Color fundus image · 50° FOV · pupil-dilated · image size 2361x1568 · macula at the center of the field — 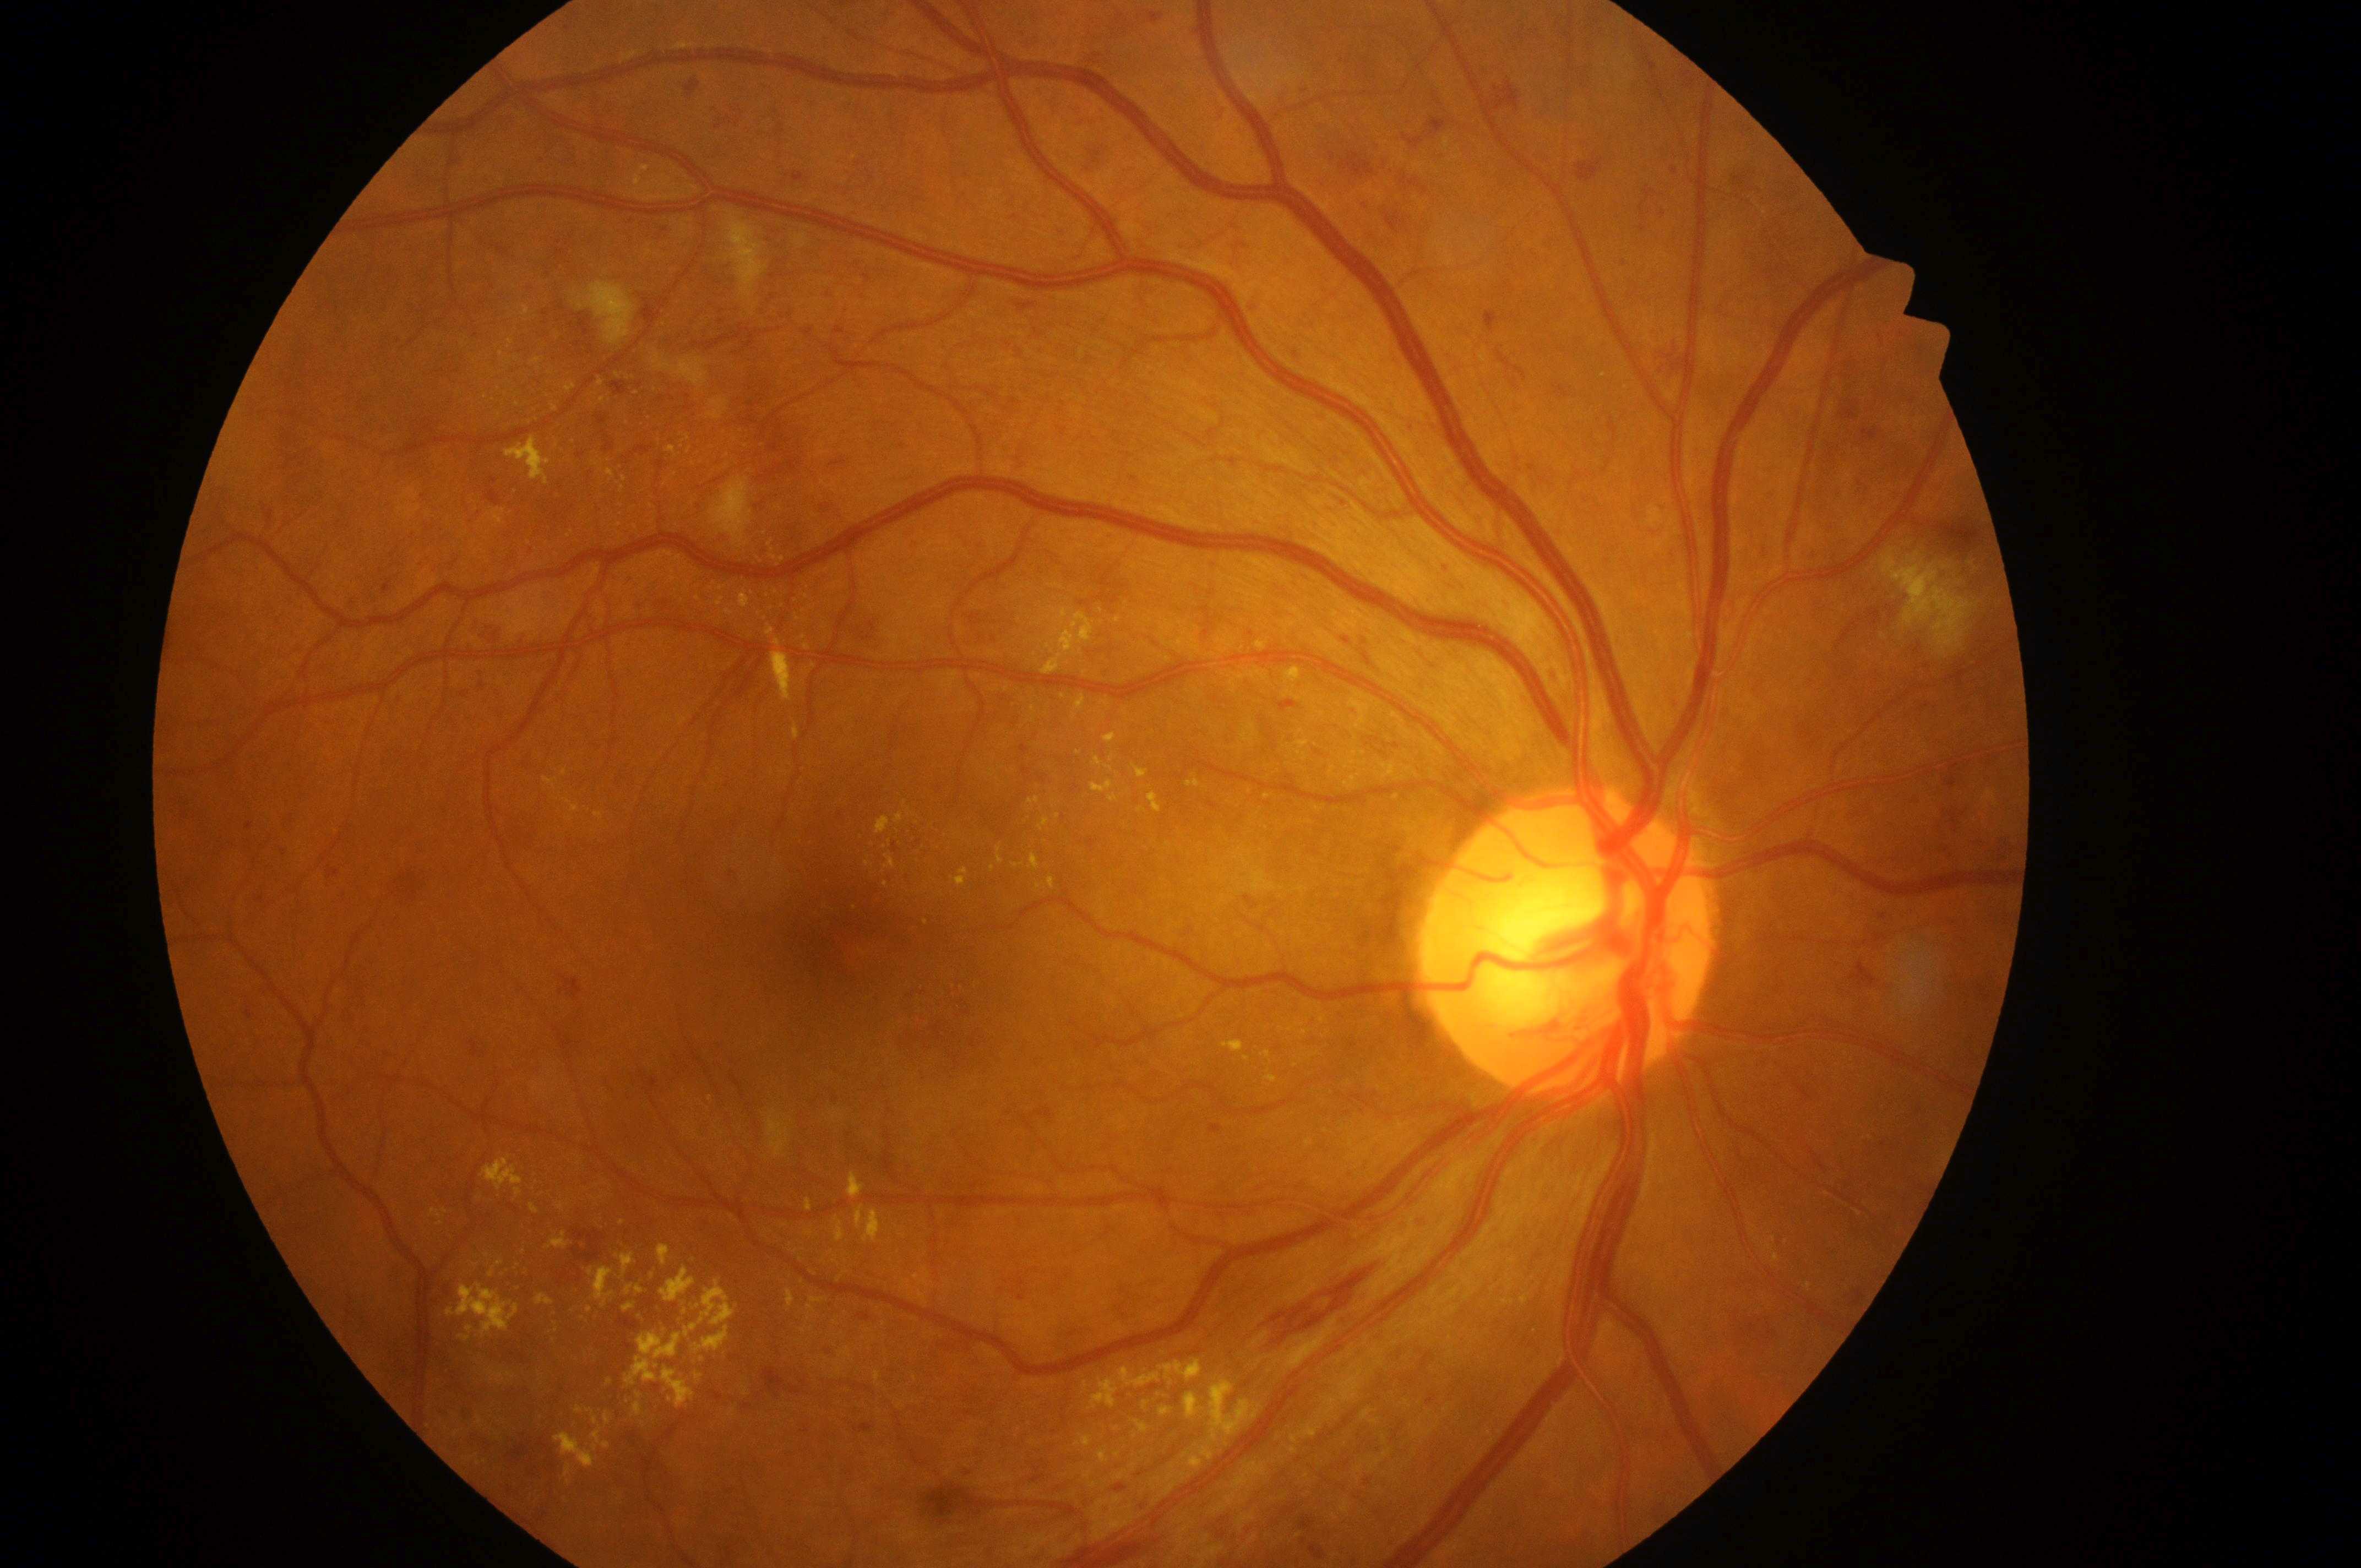

disc center: 1568, 955
risk of diabetic macular edema: 2
macula center: 844, 940
diabetic retinopathy grade: 3
non-proliferative diabetic retinopathy
the right eye